Fundus photo
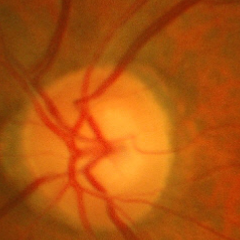
No signs of glaucoma.